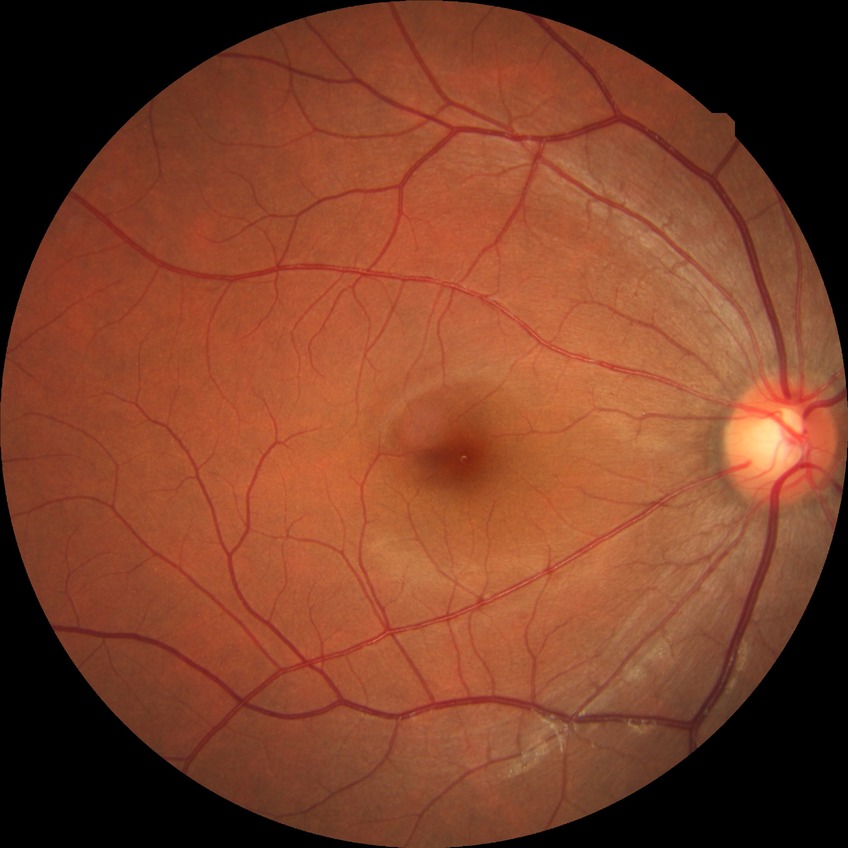
DR grade: NDR.